2048 by 1536 pixels: 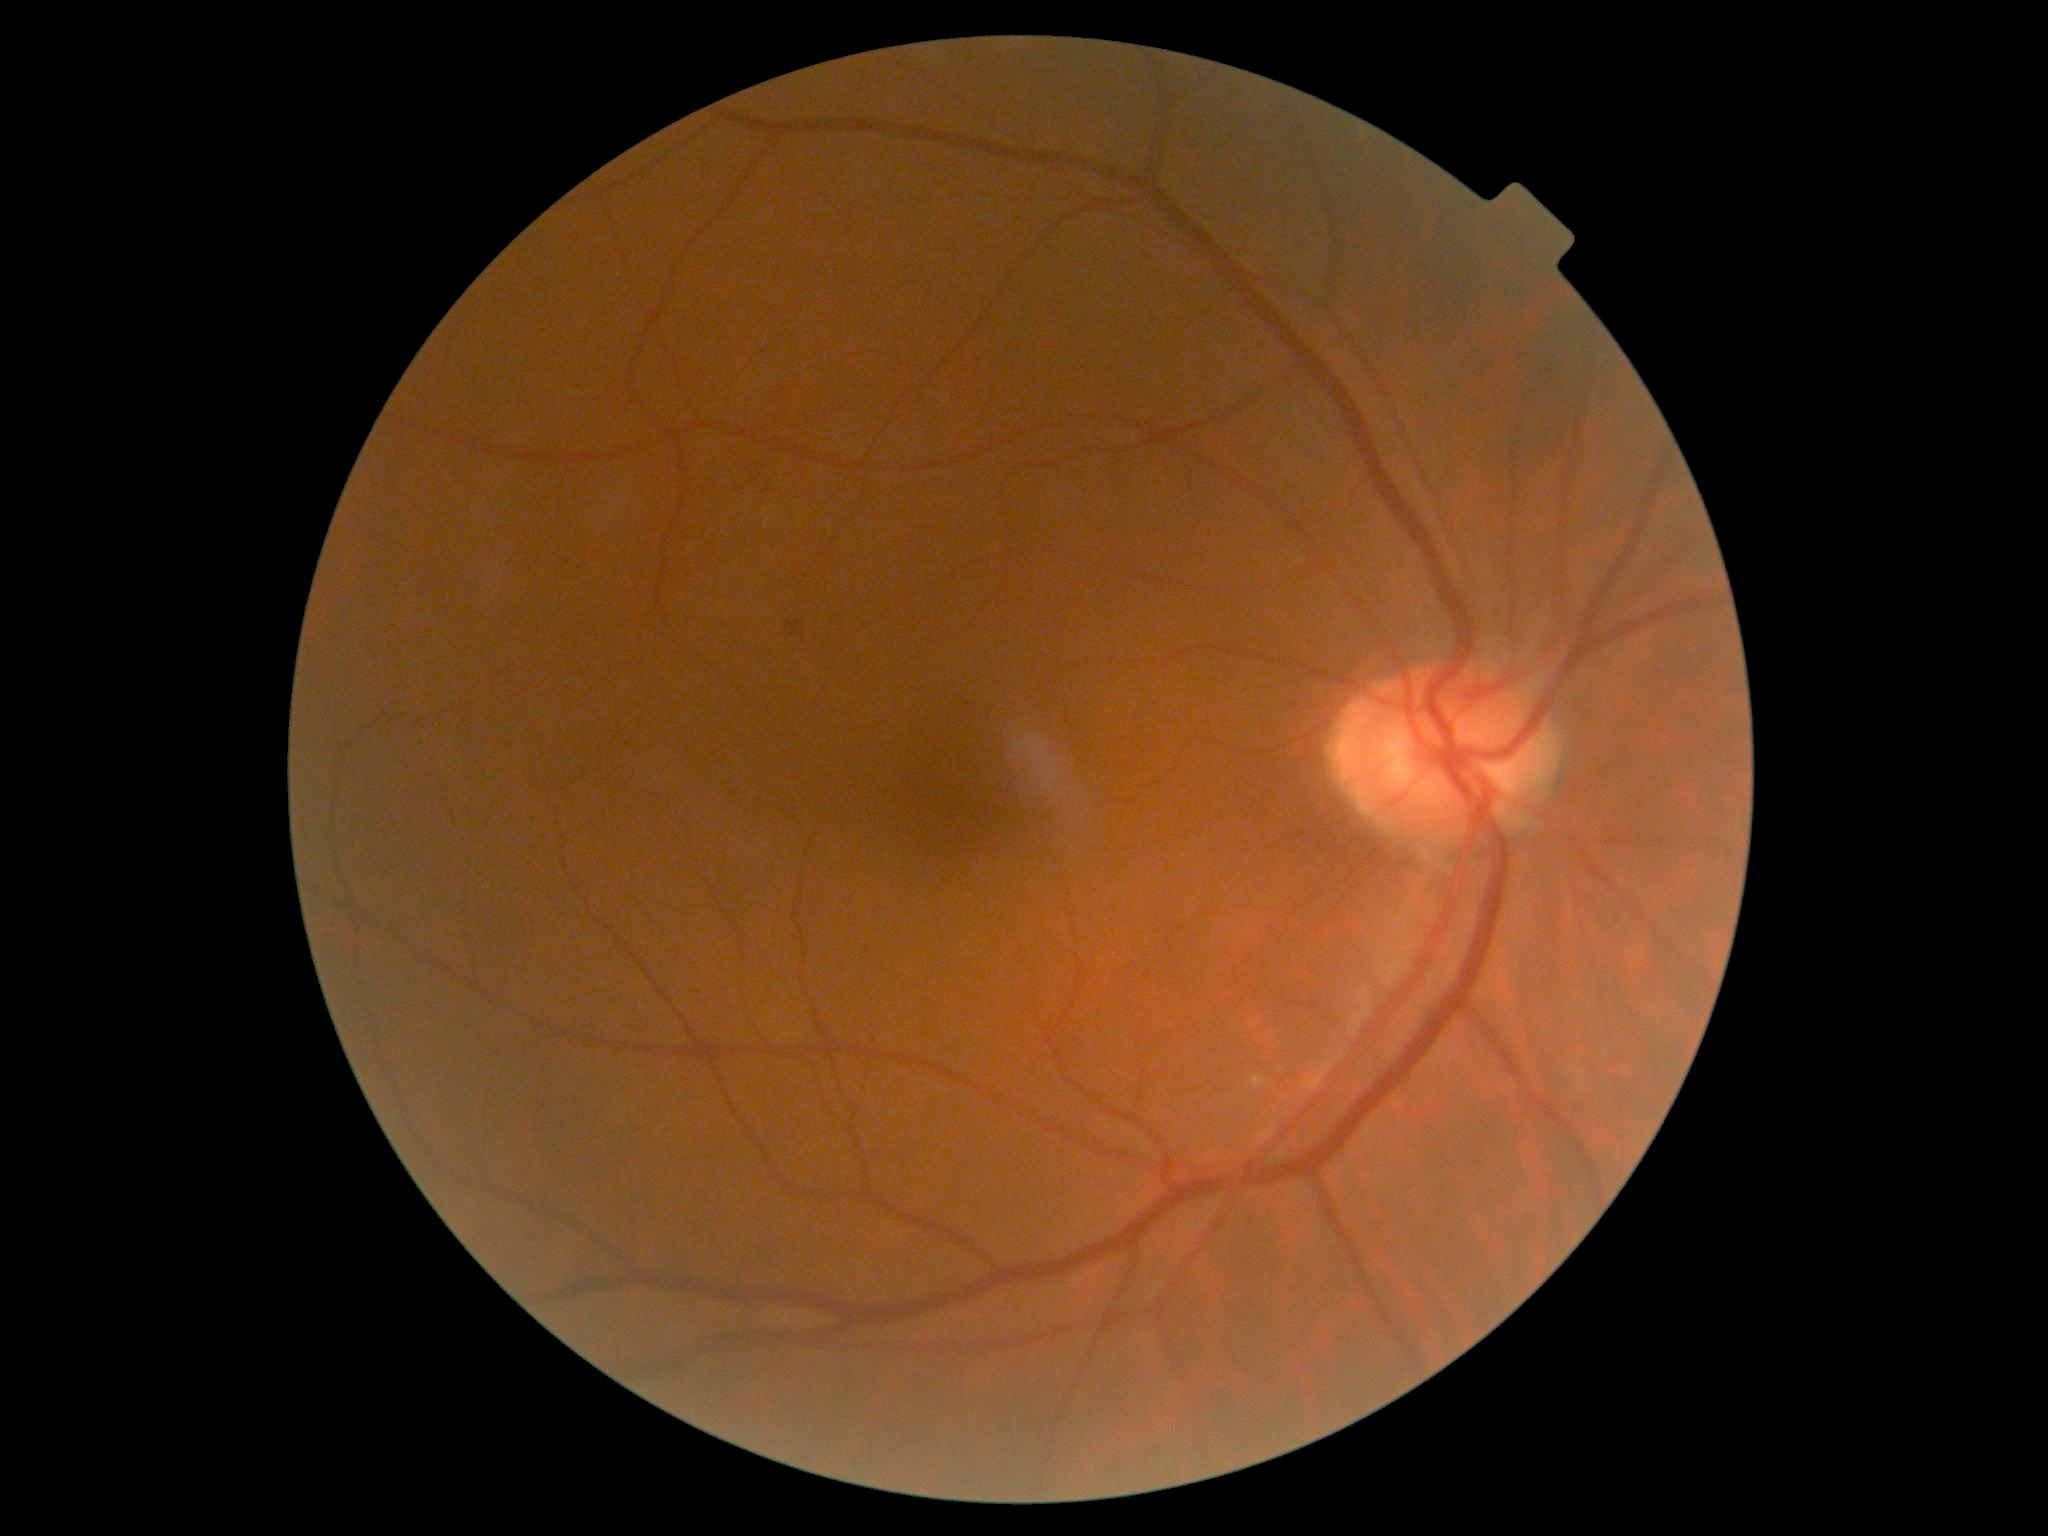

{"dr_grade":1,"lesions":{"ma":[[786,618,803,638]],"se":null,"ex":null,"he":null}}